Wide-field fundus image from infant ROP screening — 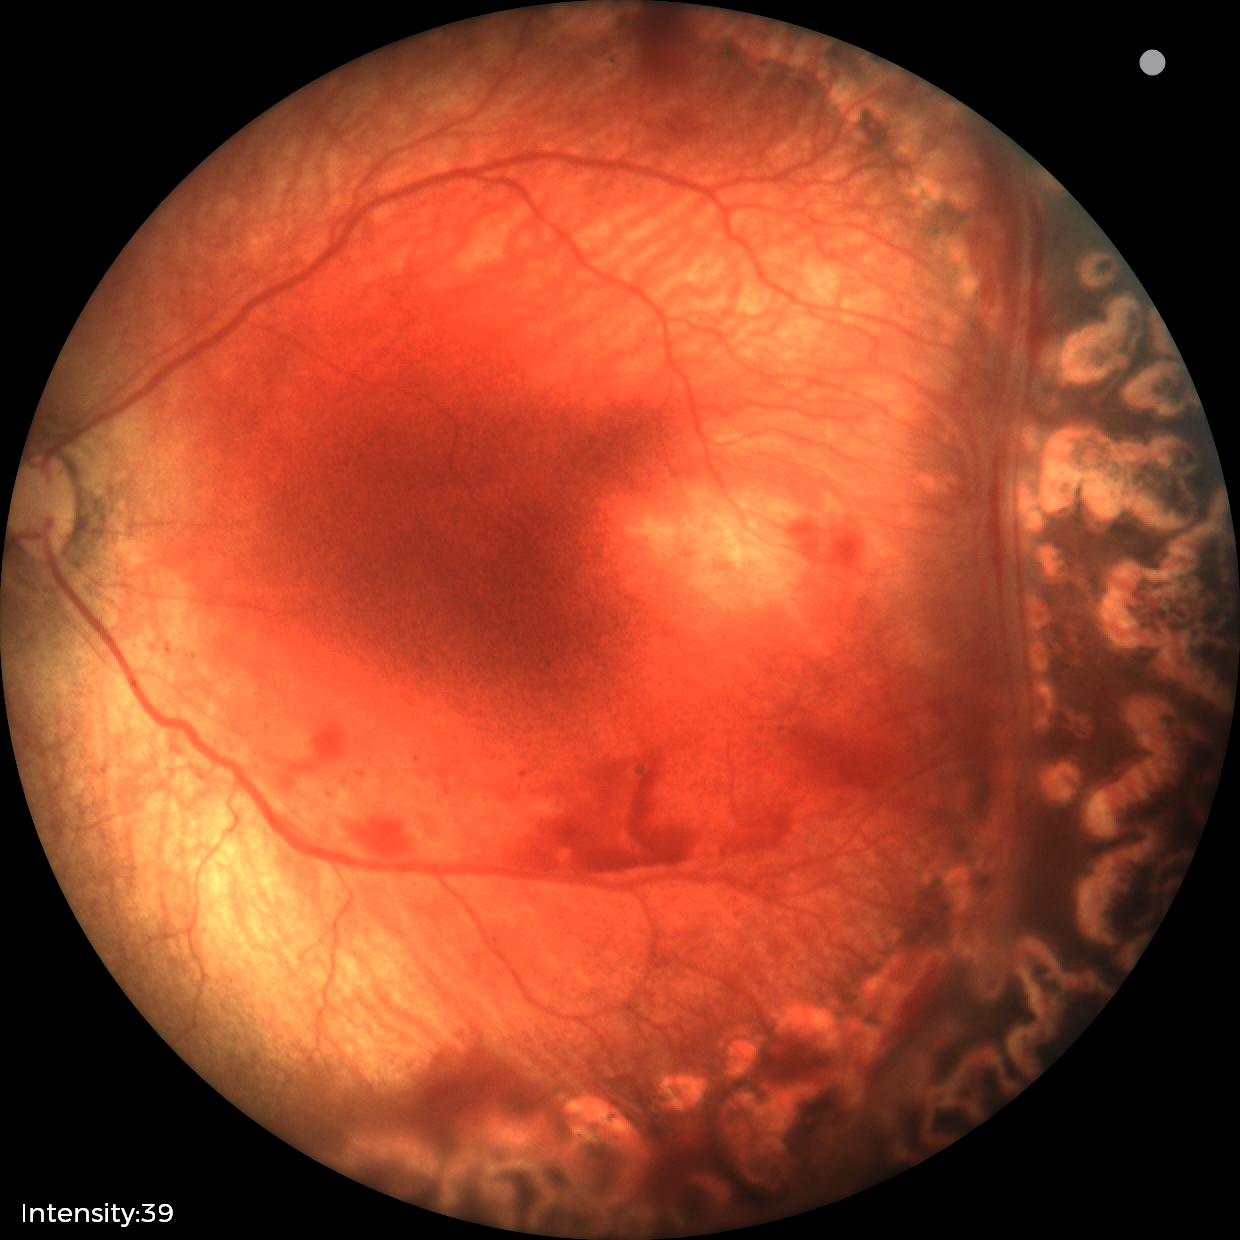

Finding = status post retinopathy of prematurity (ROP).